Diabetic retinopathy graded by the modified Davis classification: 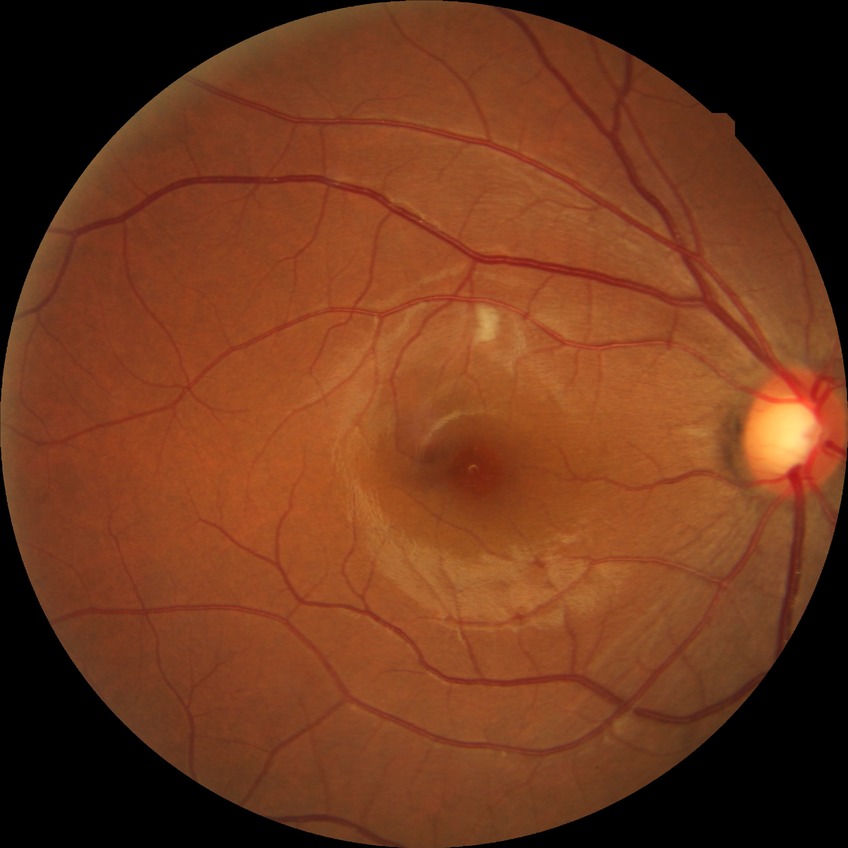
diabetic retinopathy (DR): simple diabetic retinopathy (SDR).